Diabetic retinopathy graded by the modified Davis classification; nonmydriatic — 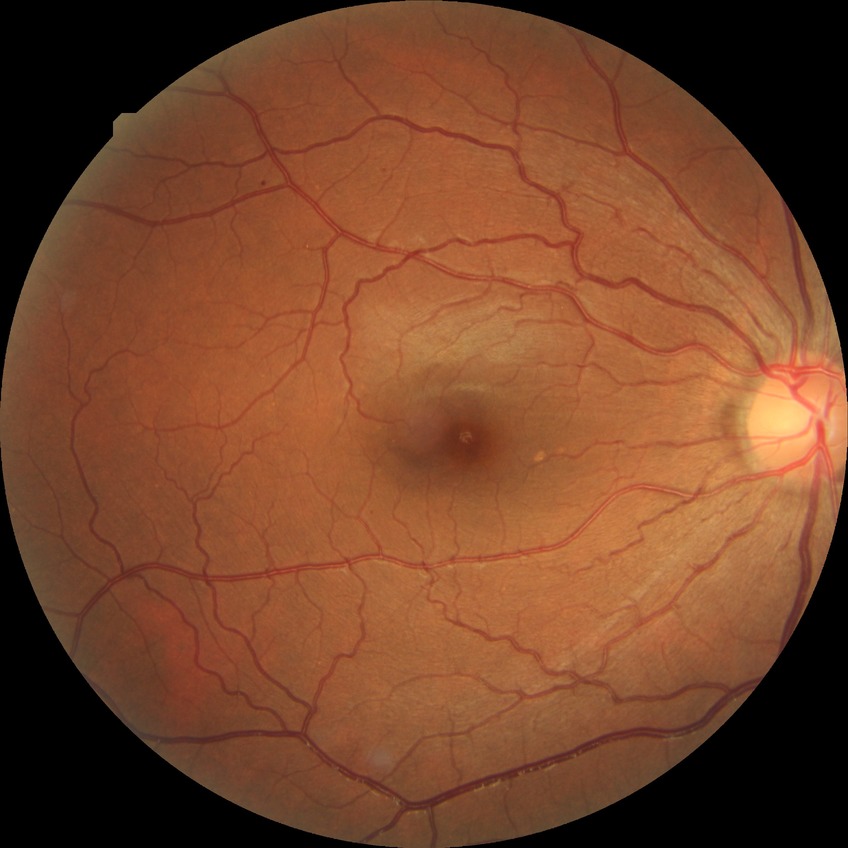
Diabetic retinopathy (DR): simple diabetic retinopathy (SDR).